CFP · 848x848px: 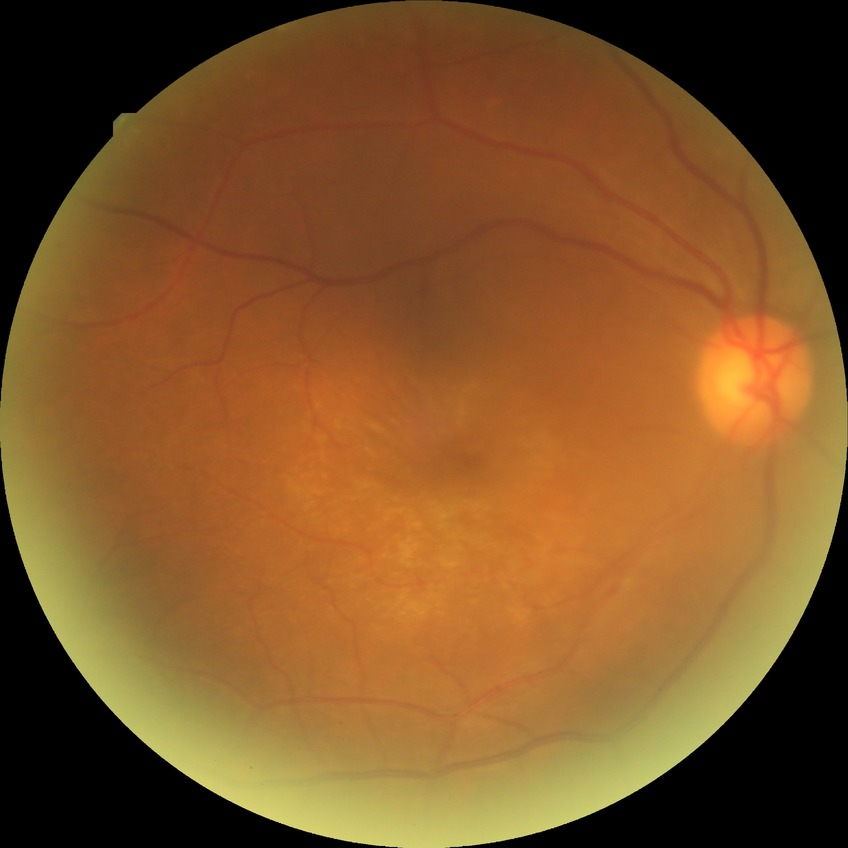 • Davis grading: no diabetic retinopathy